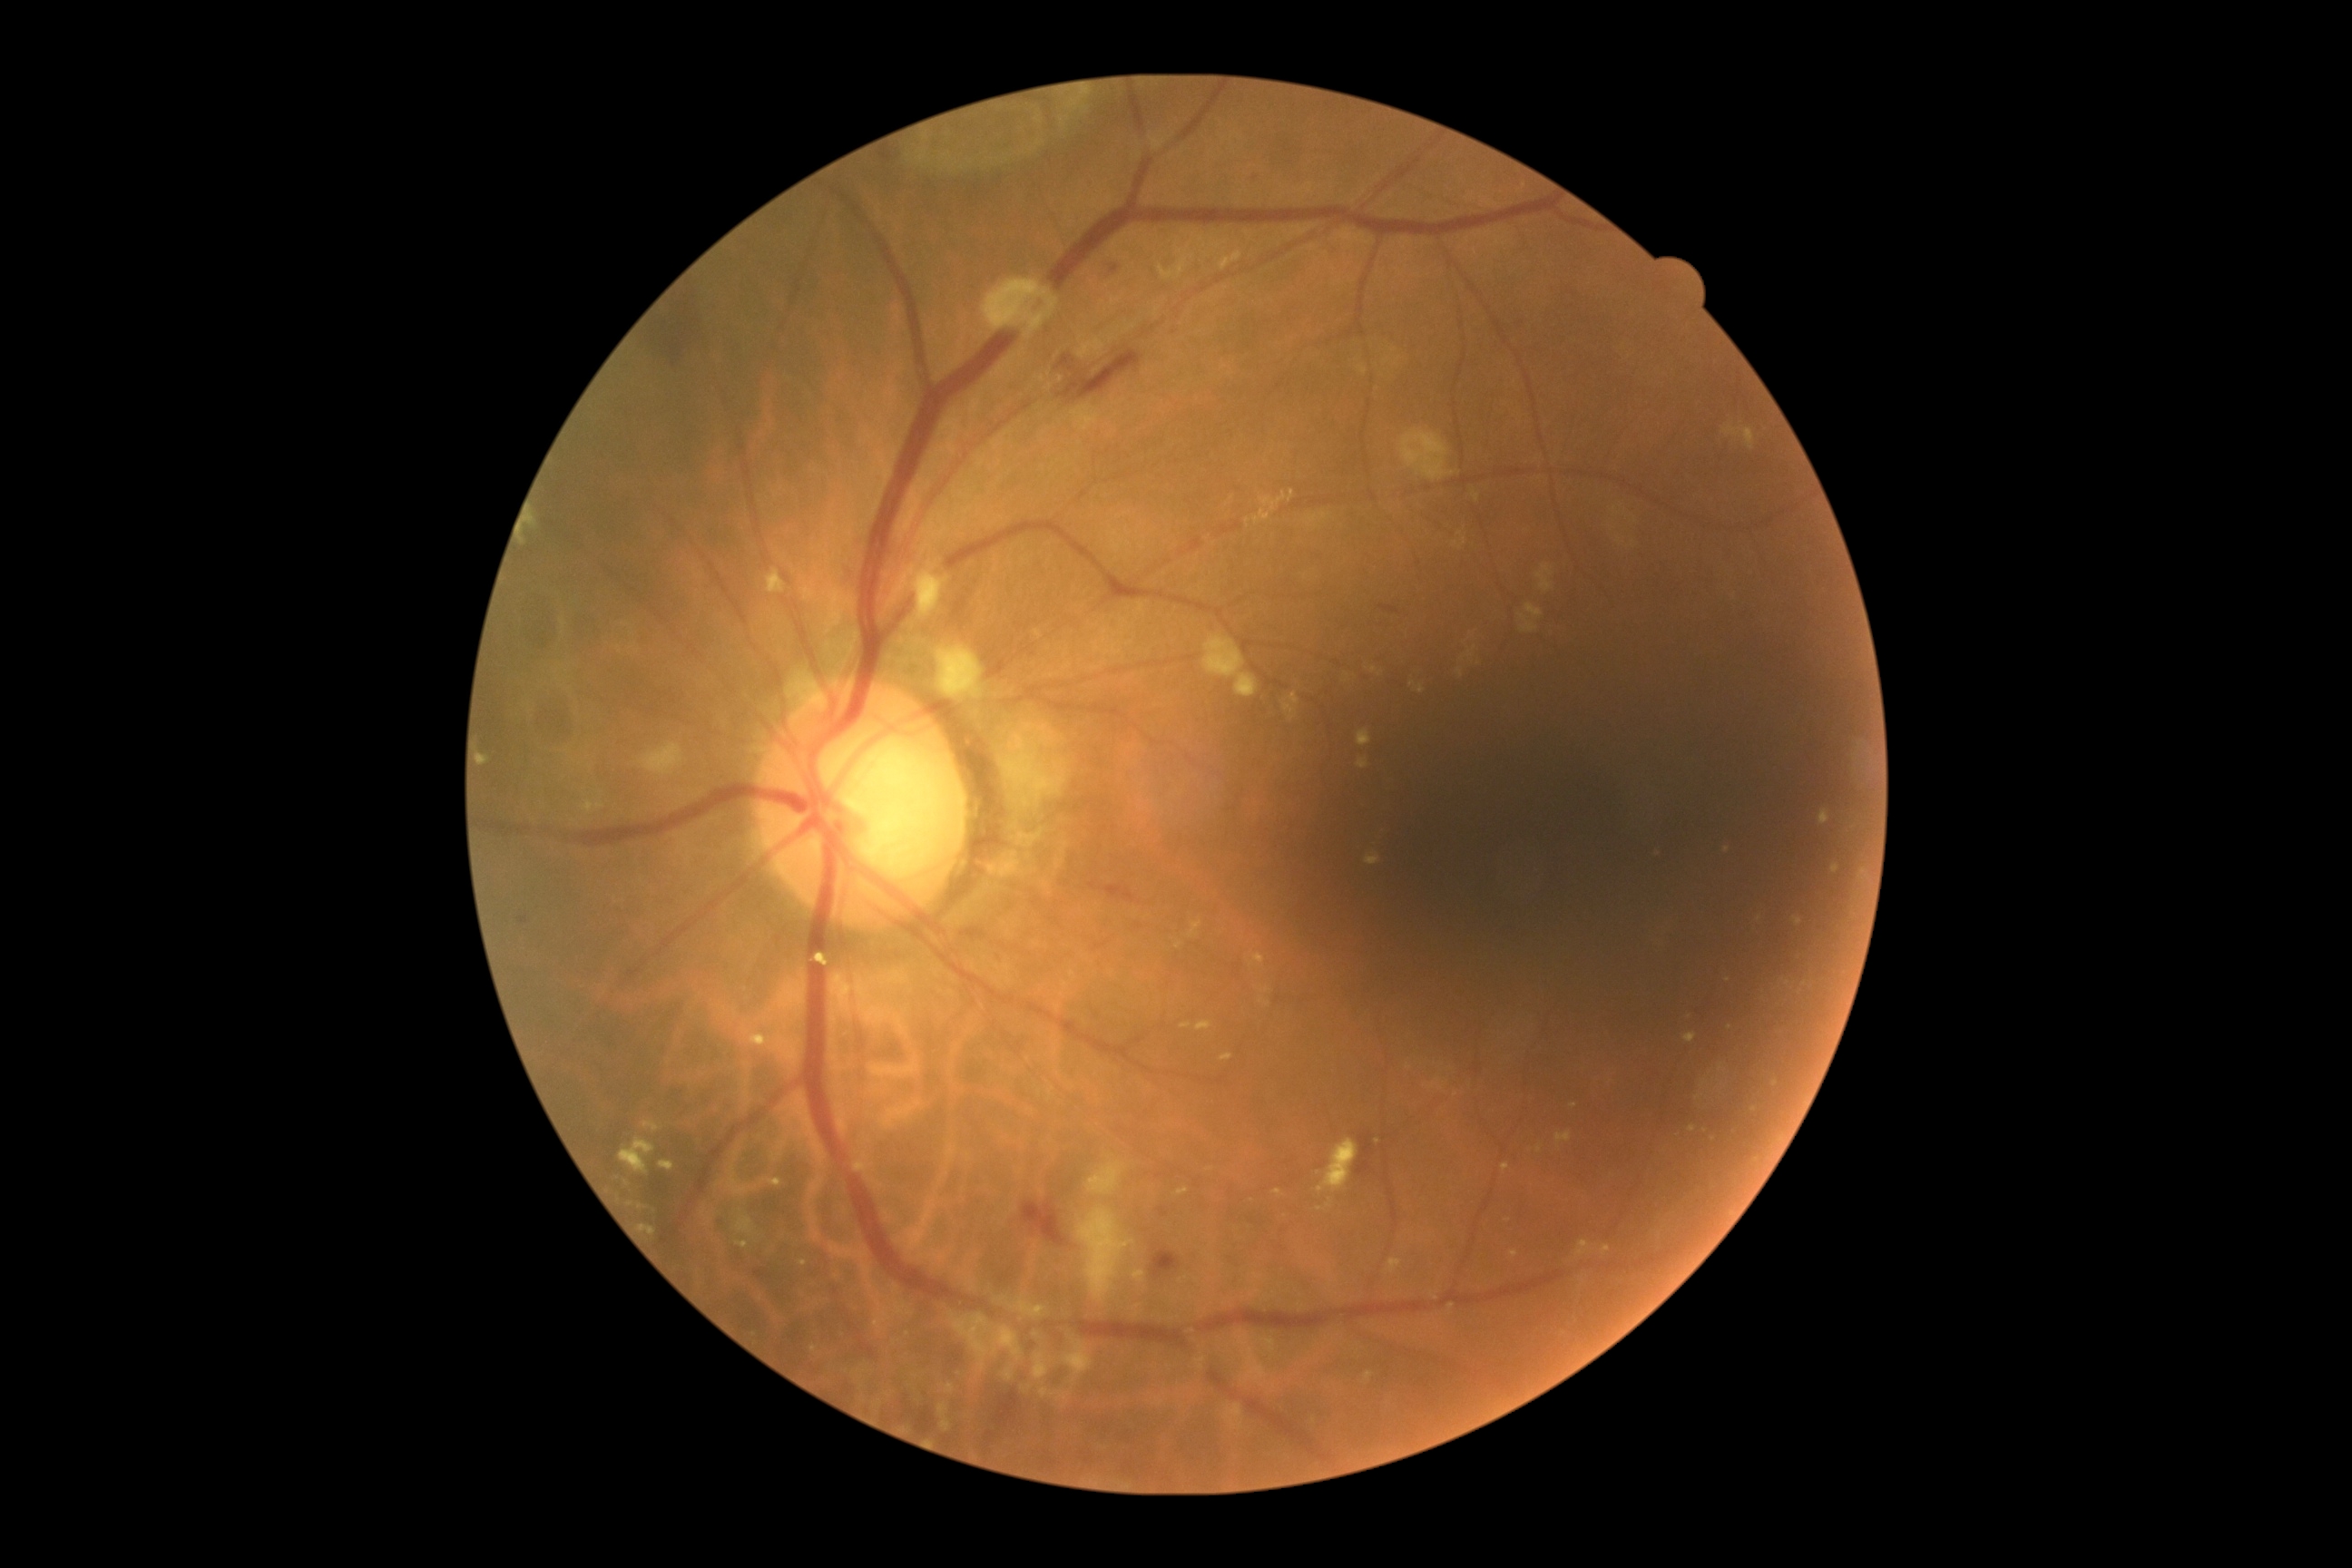 dr_category: non-proliferative diabetic retinopathy
dr_grade: moderate non-proliferative diabetic retinopathy (grade 2)